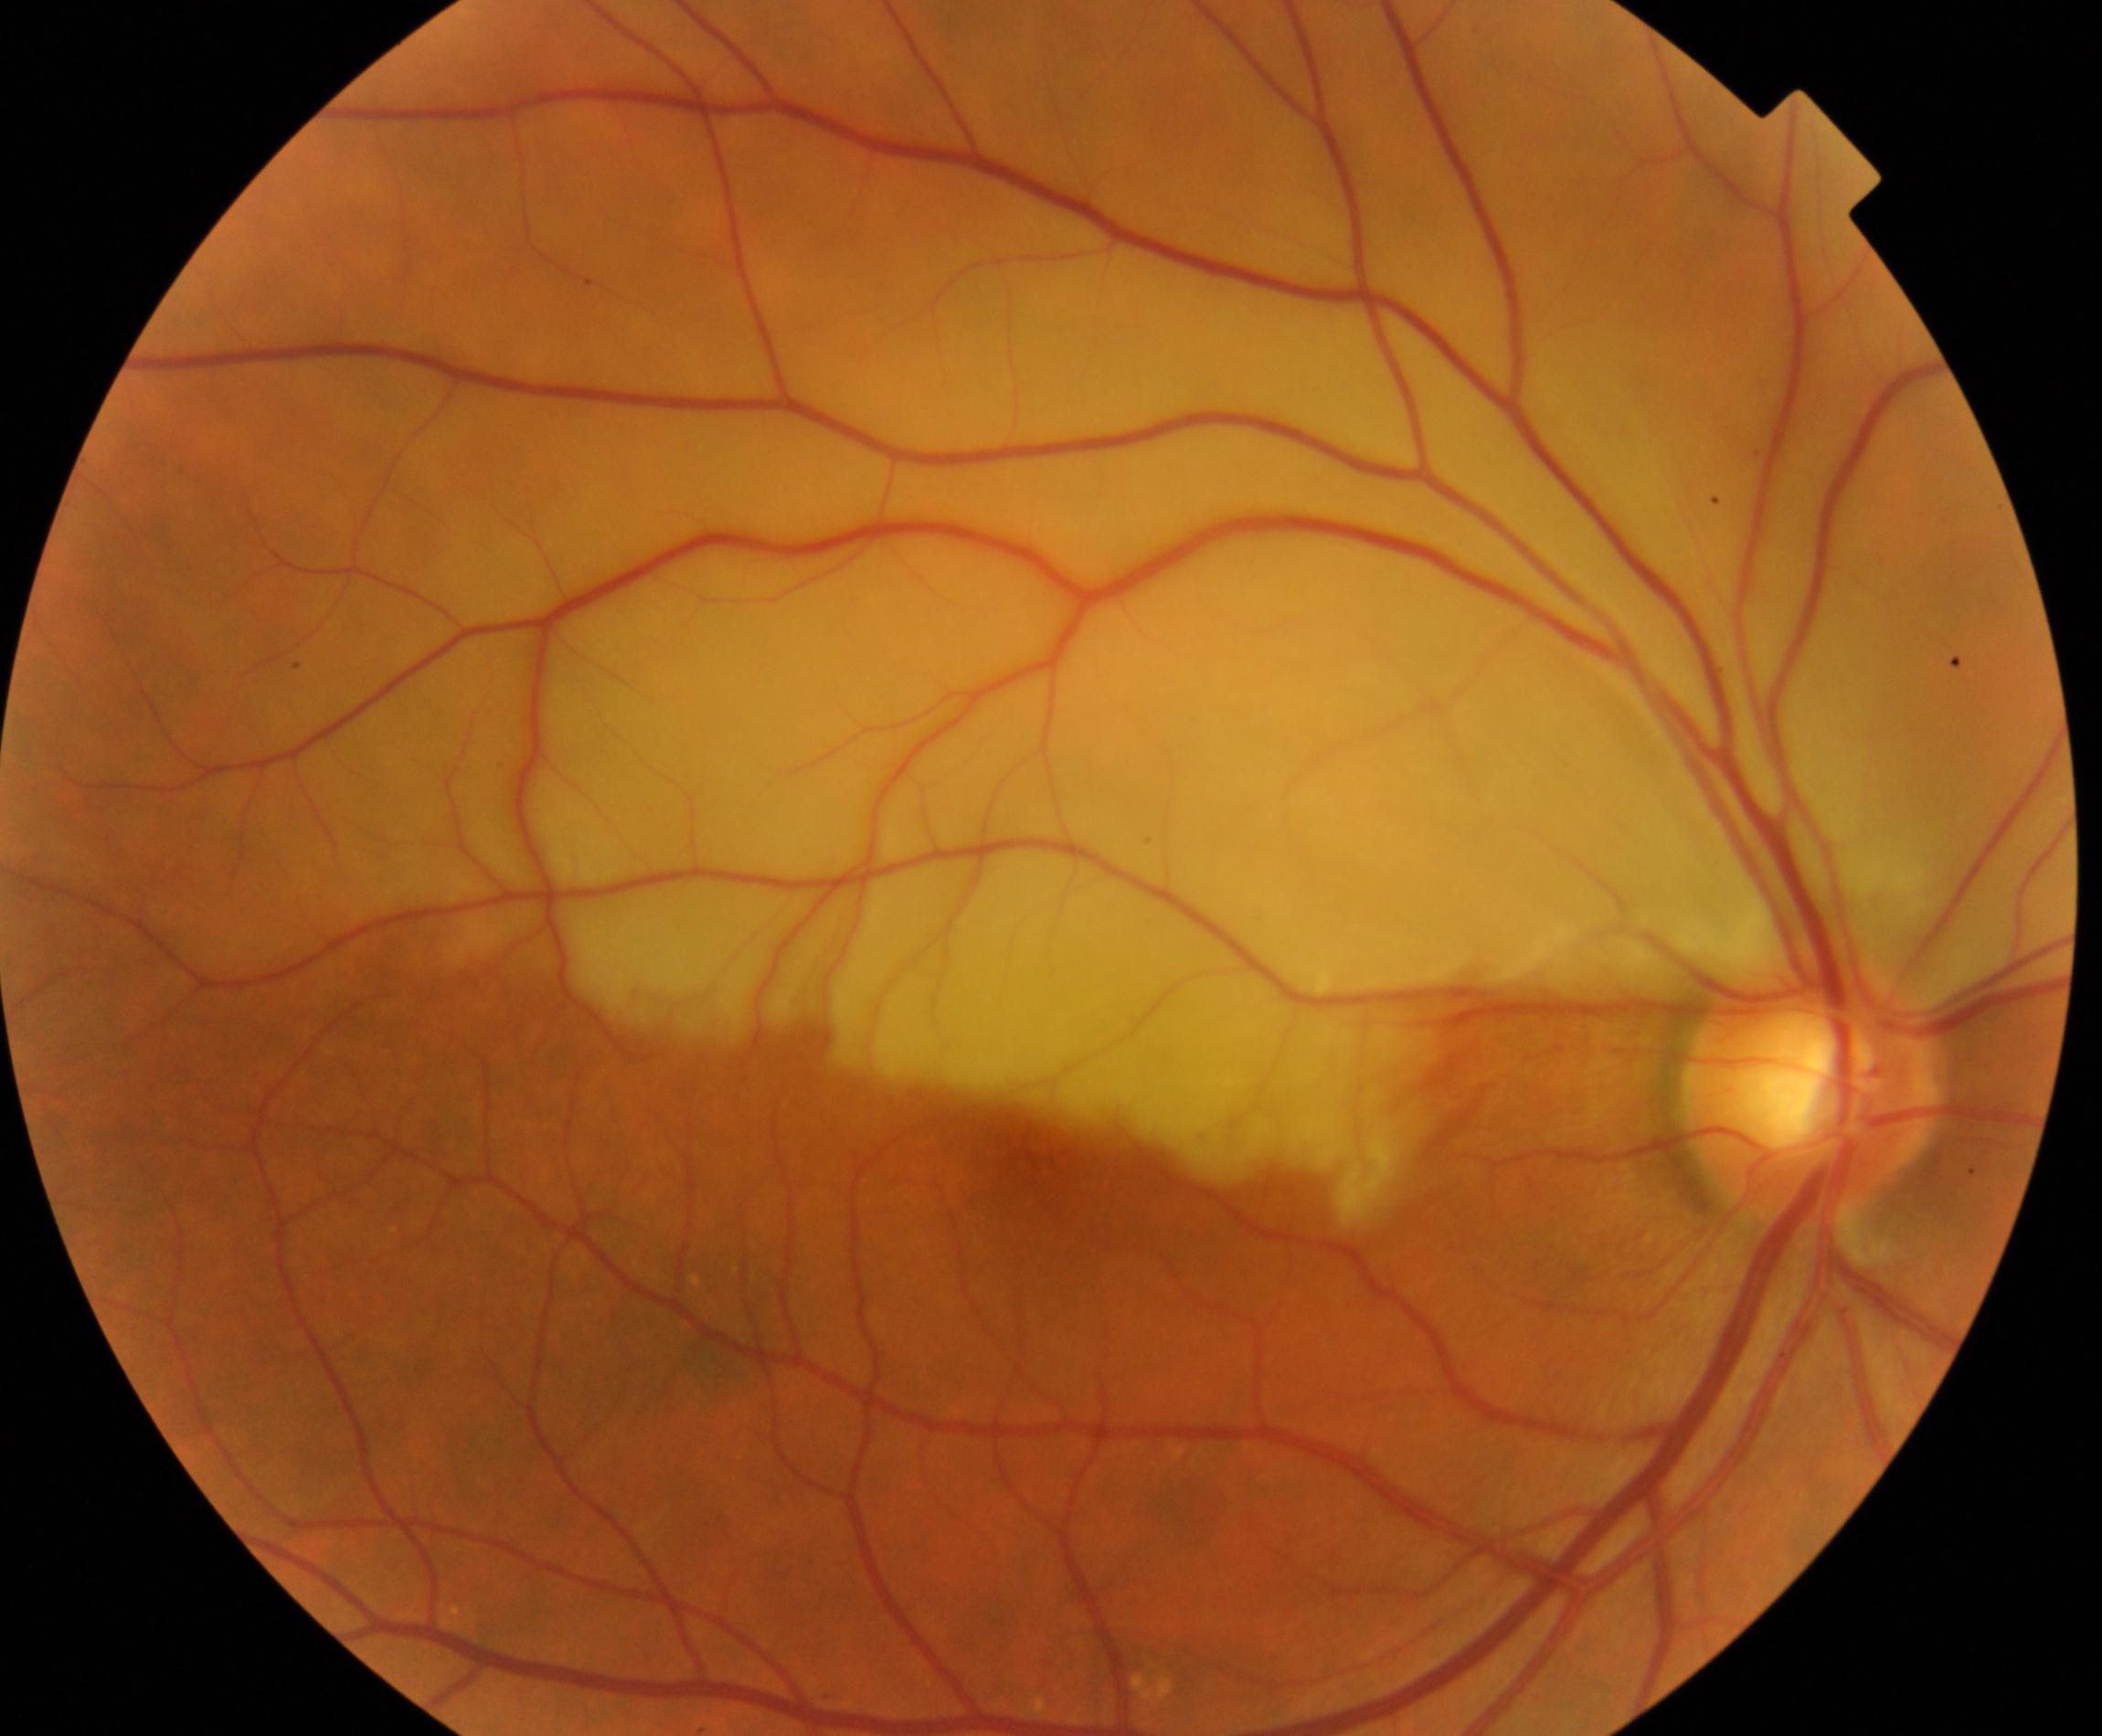

There is evidence of retinal artery occlusion.